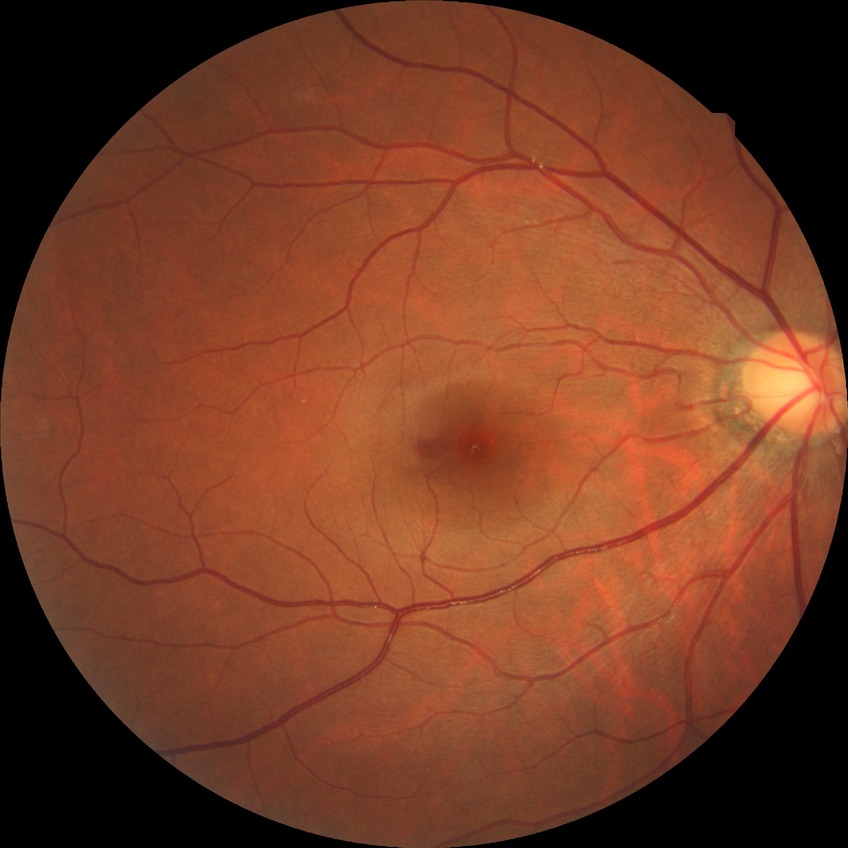 modified Davis grade: NDR, DR impression: negative for DR.